Wide-field contact fundus photograph of an infant — 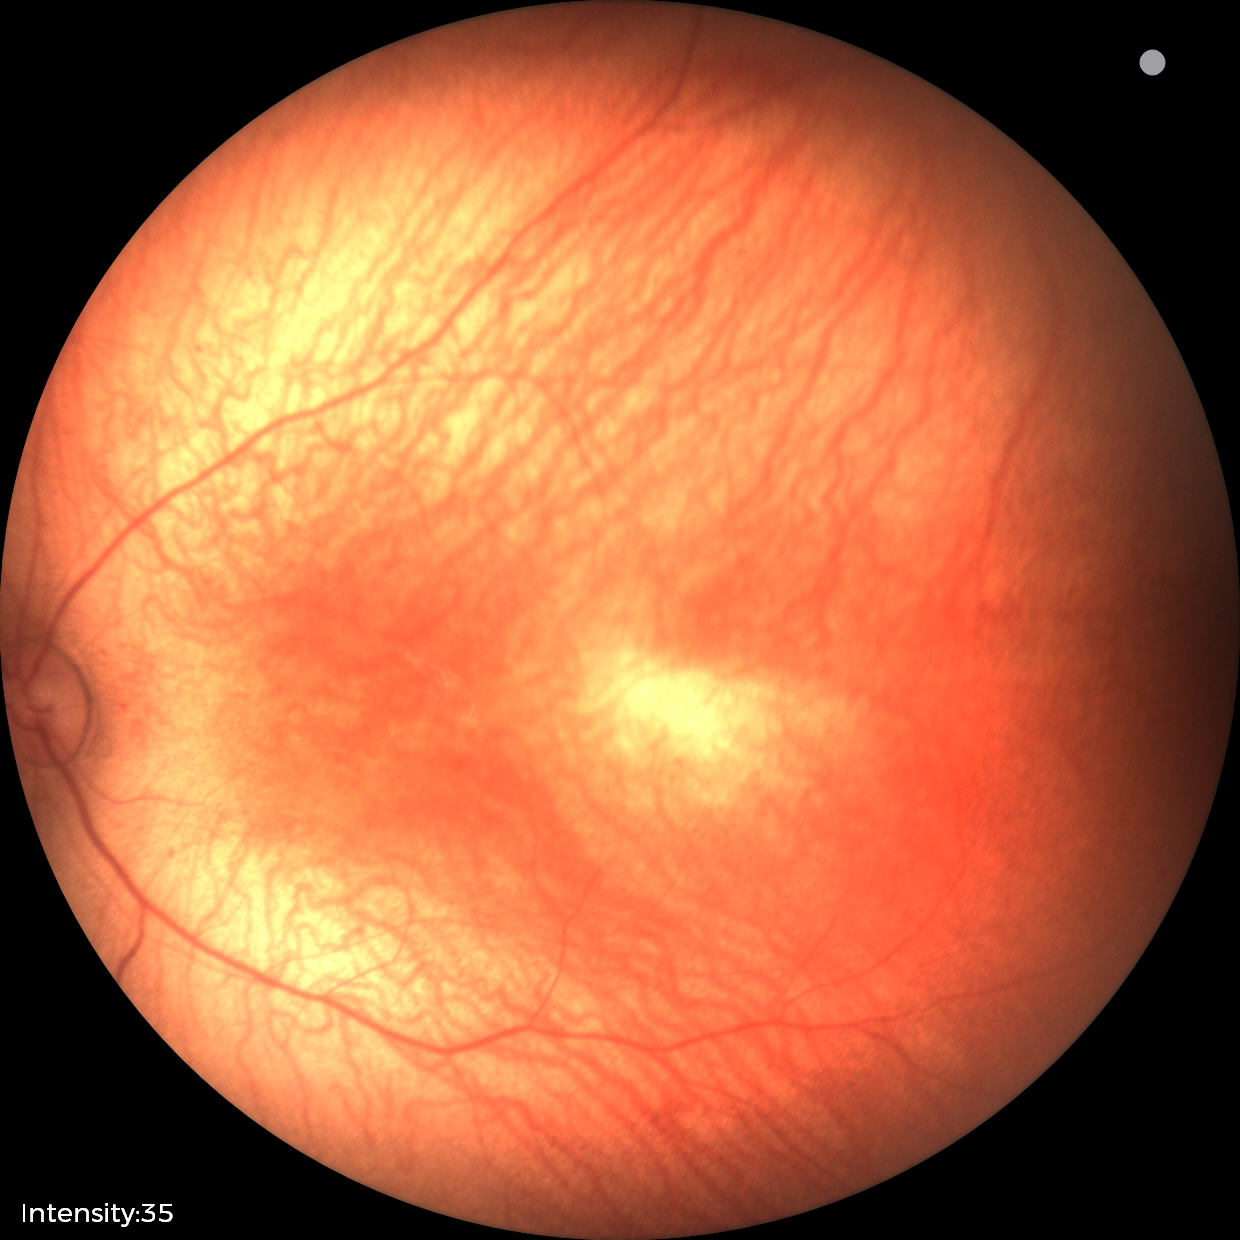

Assessment: physiological appearance with no retinal pathology.